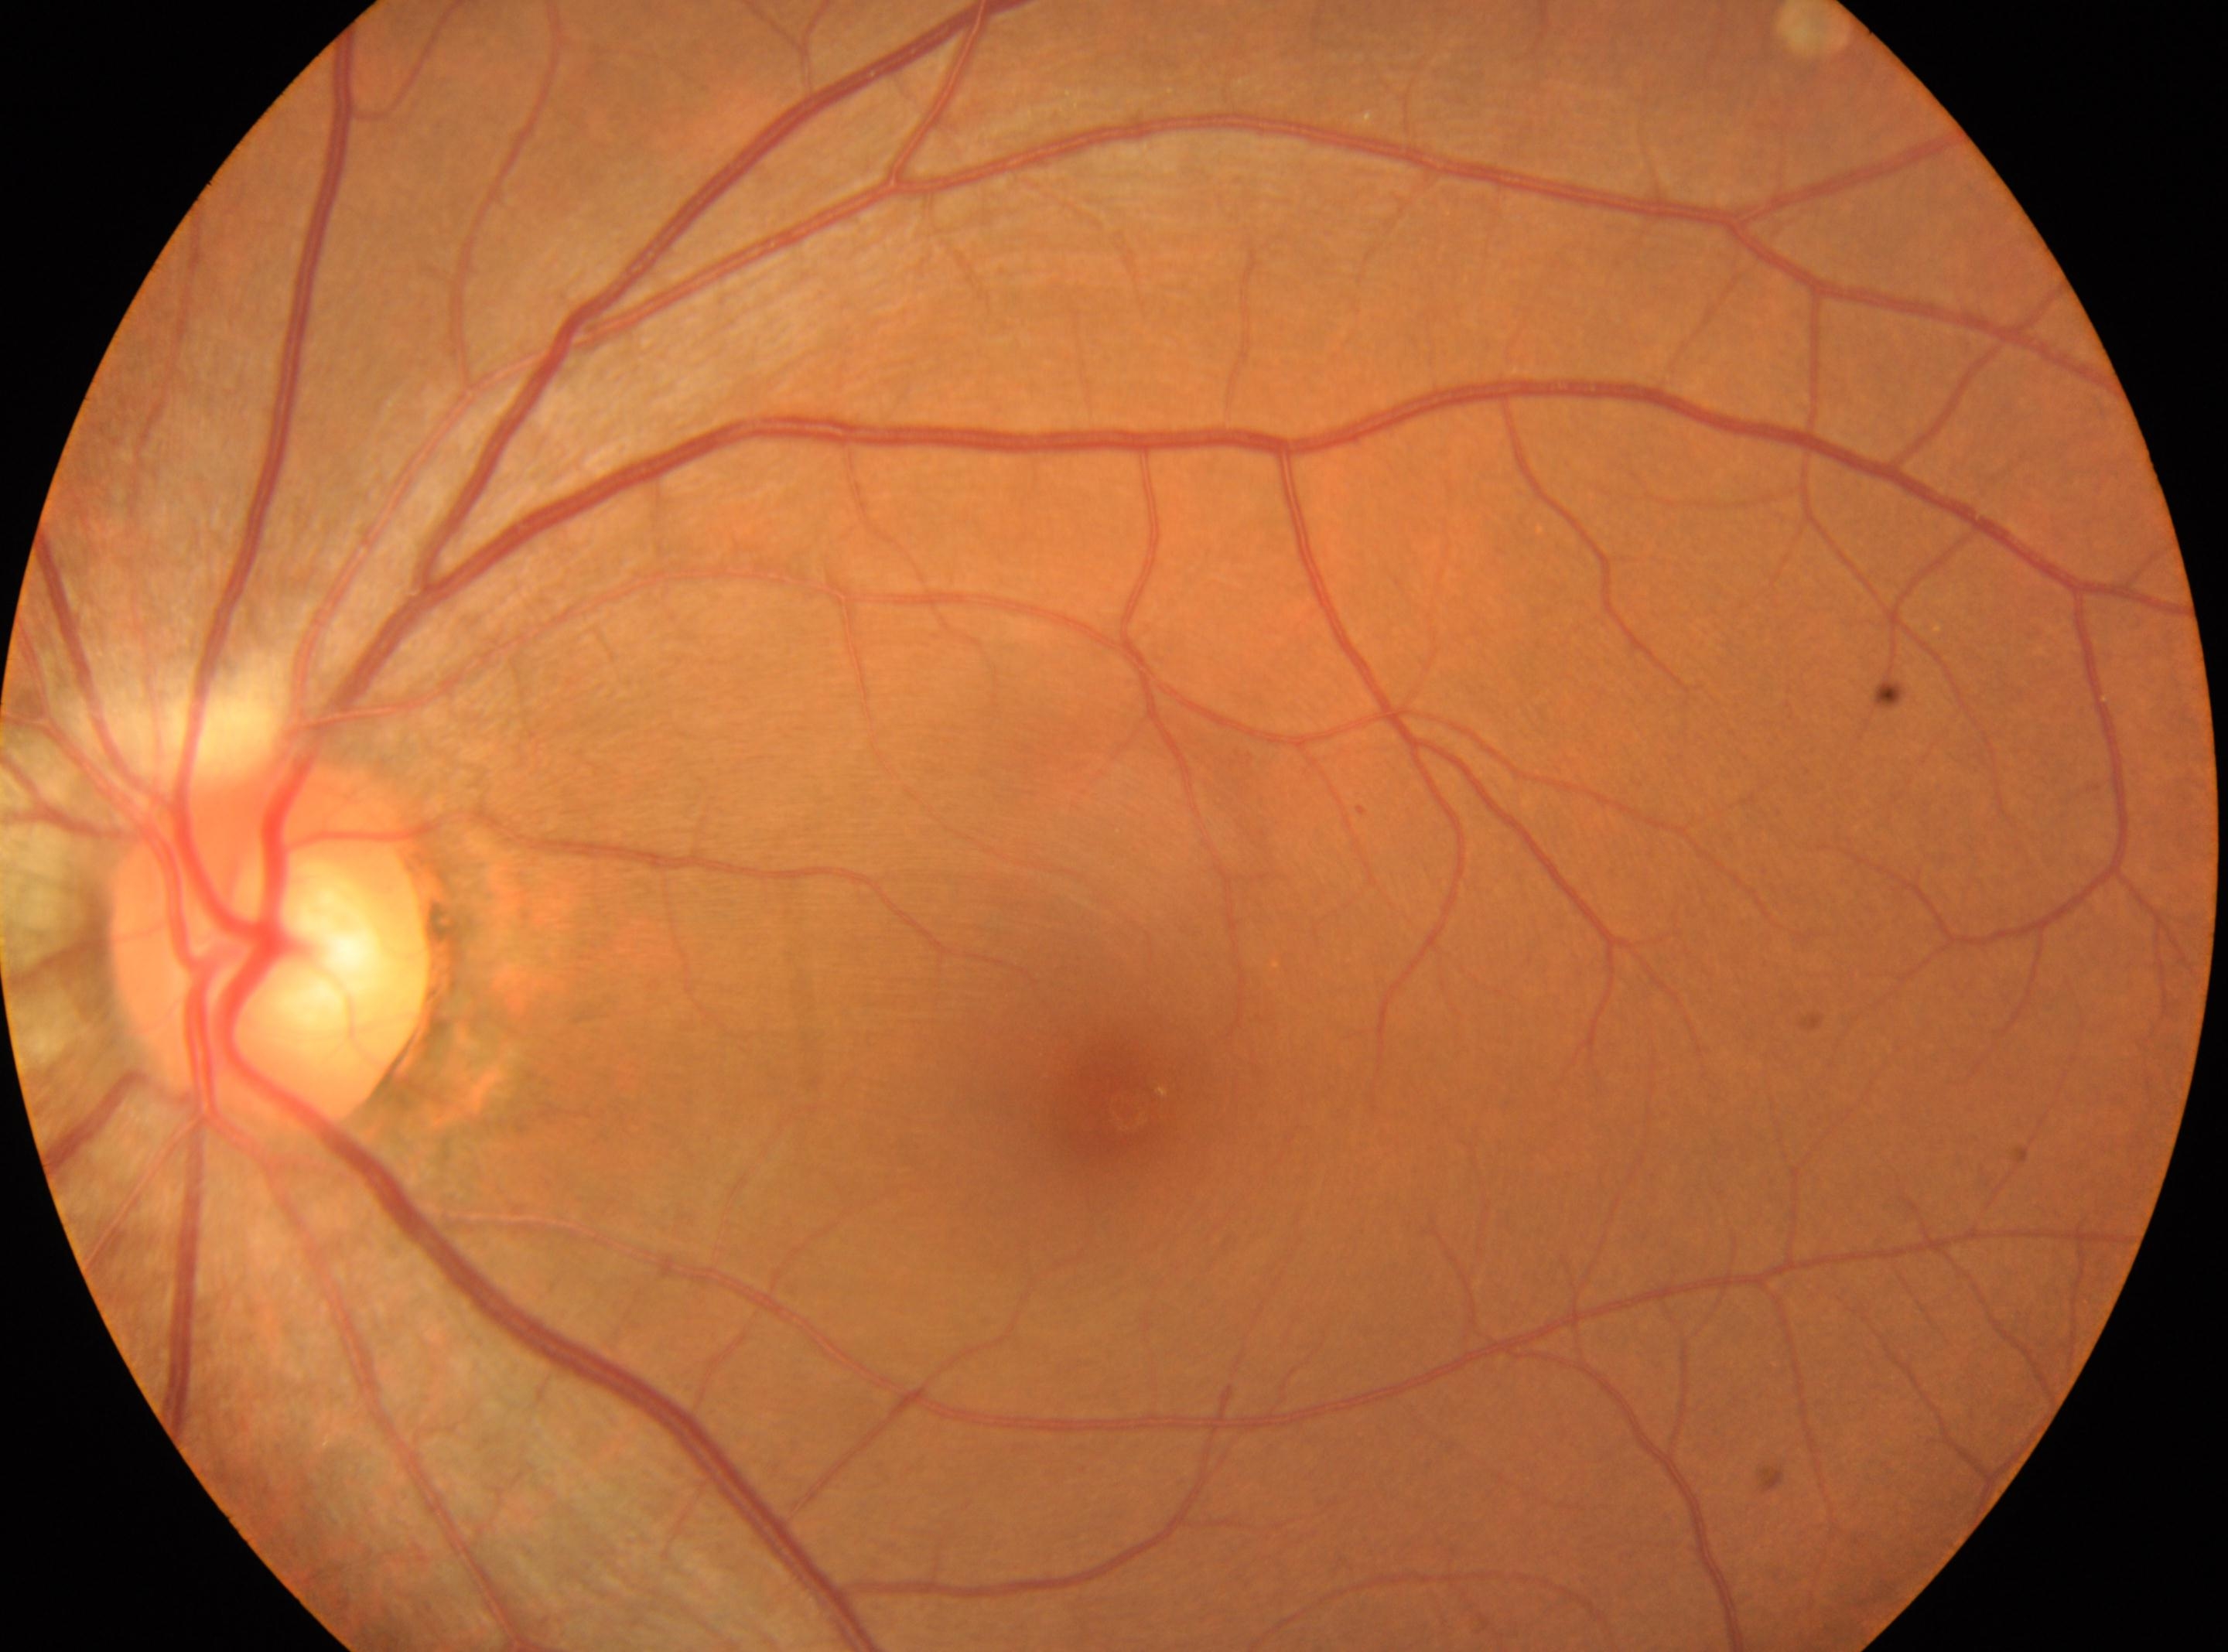

DR severity is mild NPDR (grade 1).
The ONH is at (x: 269, y: 951).
Eye: left.
The fovea is at (x: 1126, y: 1111).